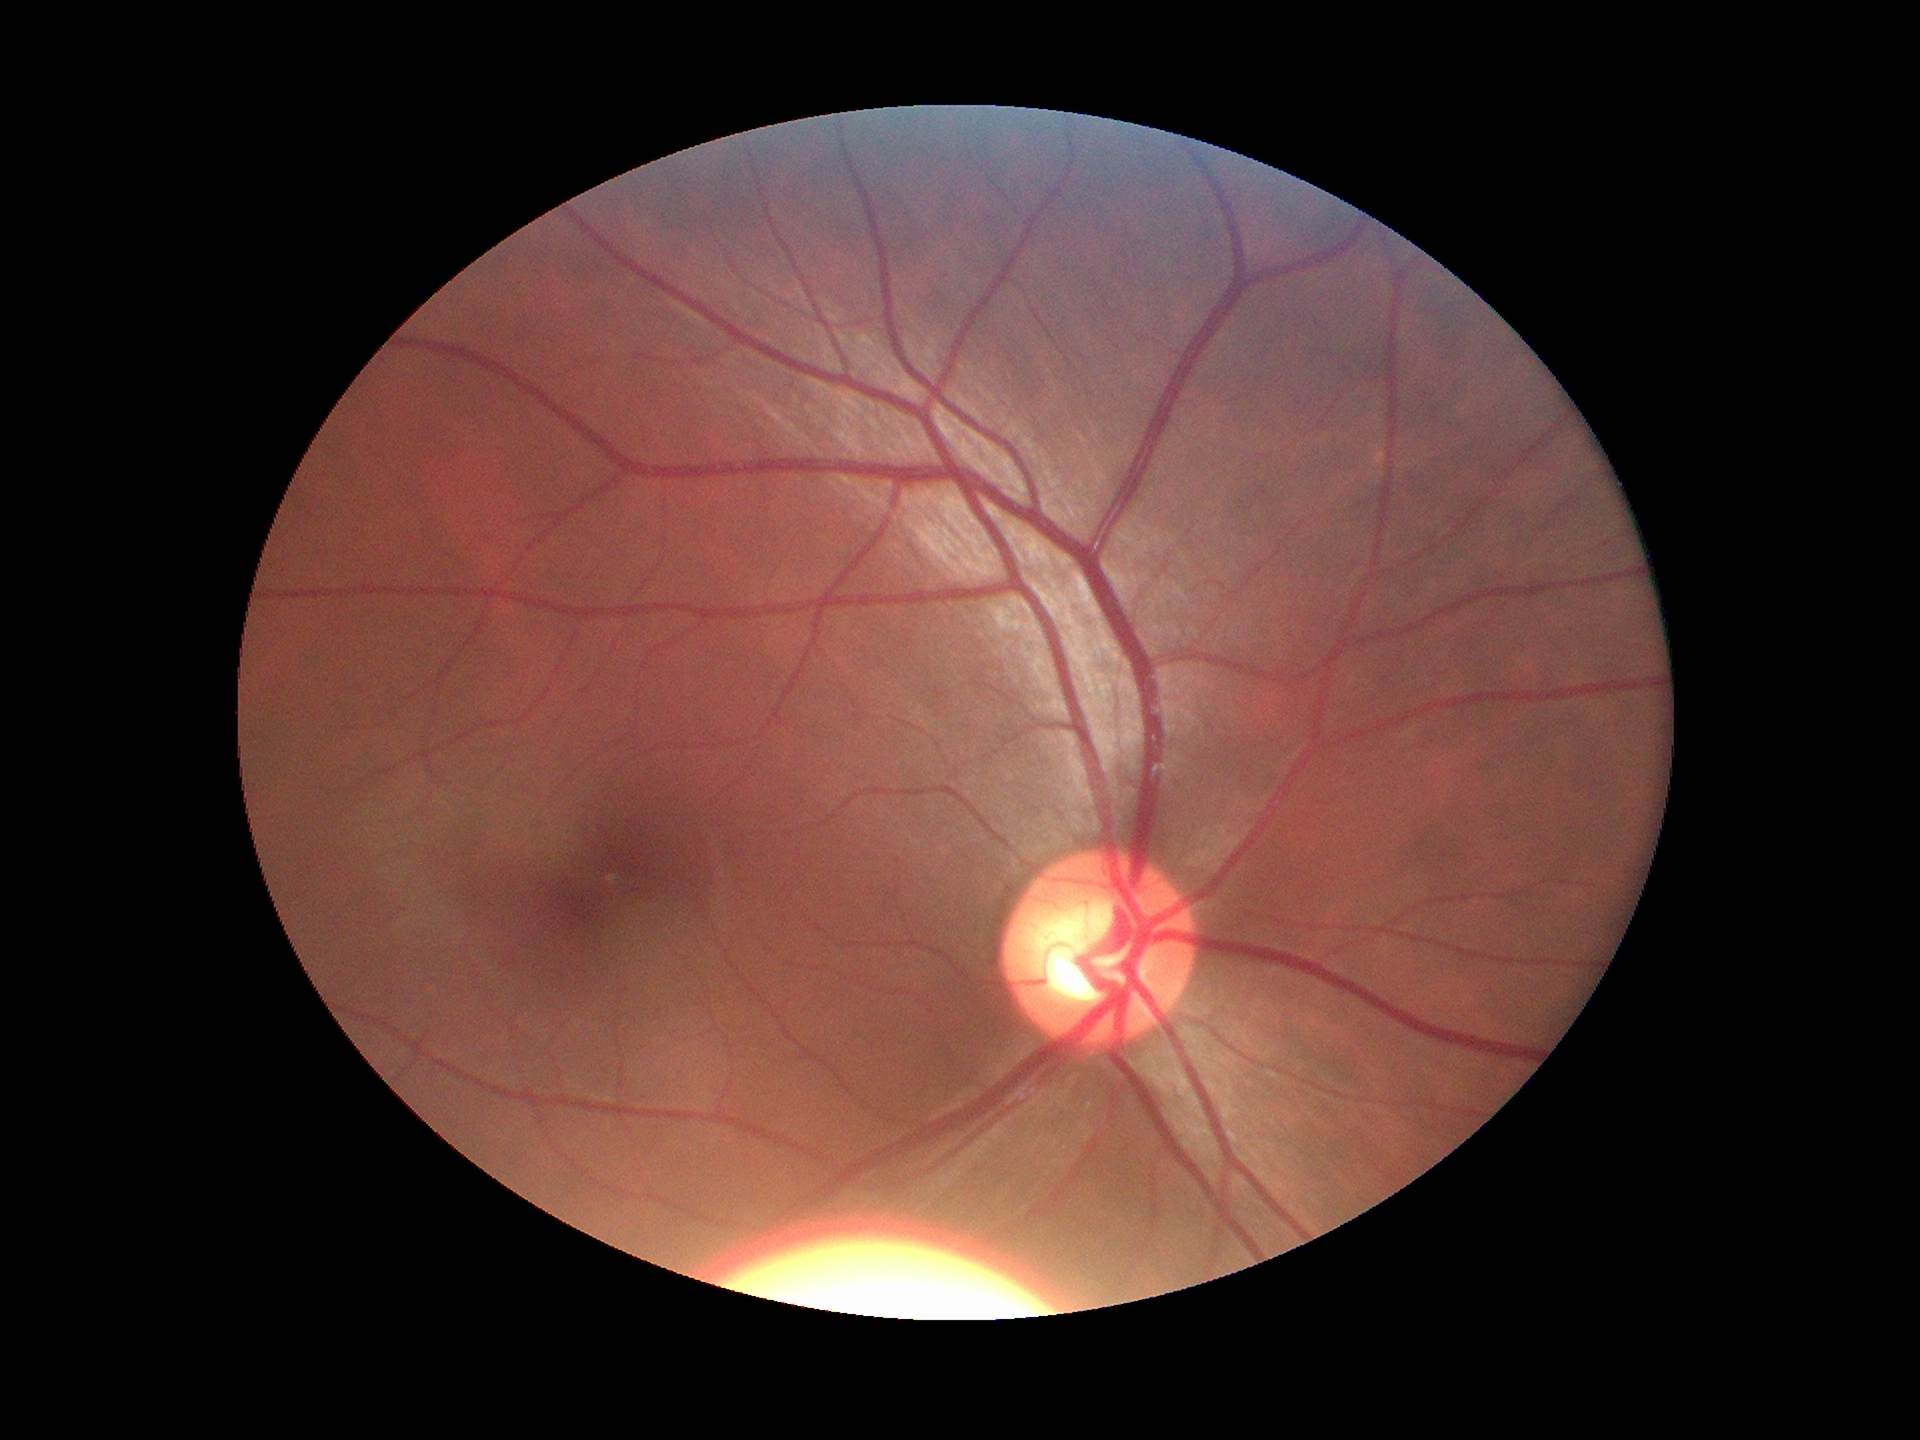 VCDR: 0.54; Glaucoma impression: negative; HCDR: 0.59